45° field of view, 1725x1721px: 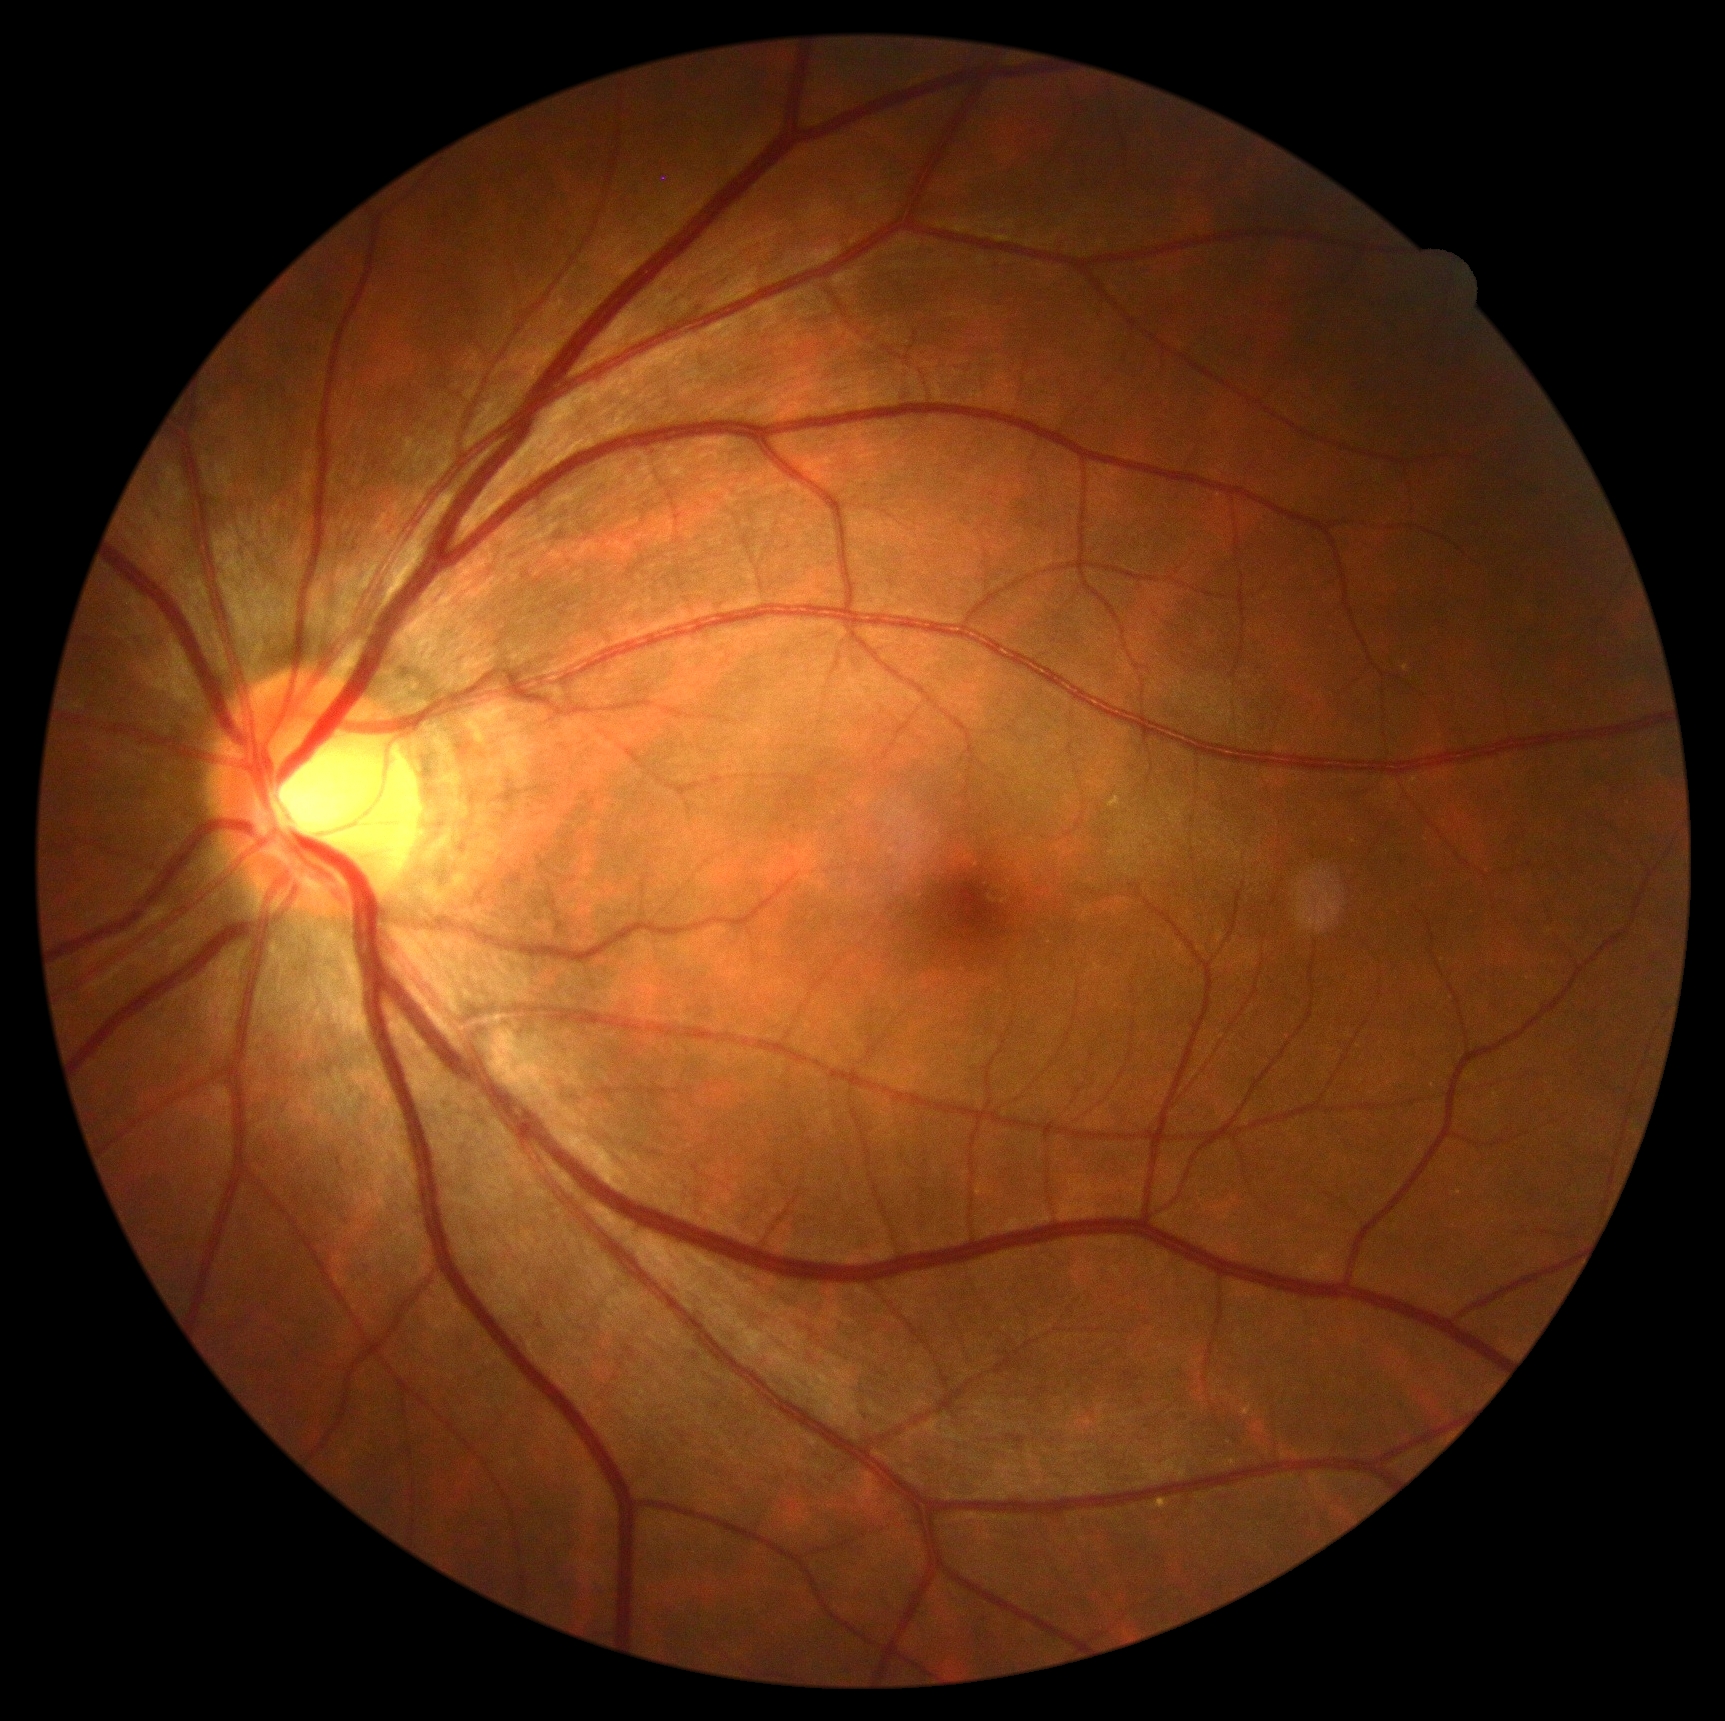

dr_grade: 0